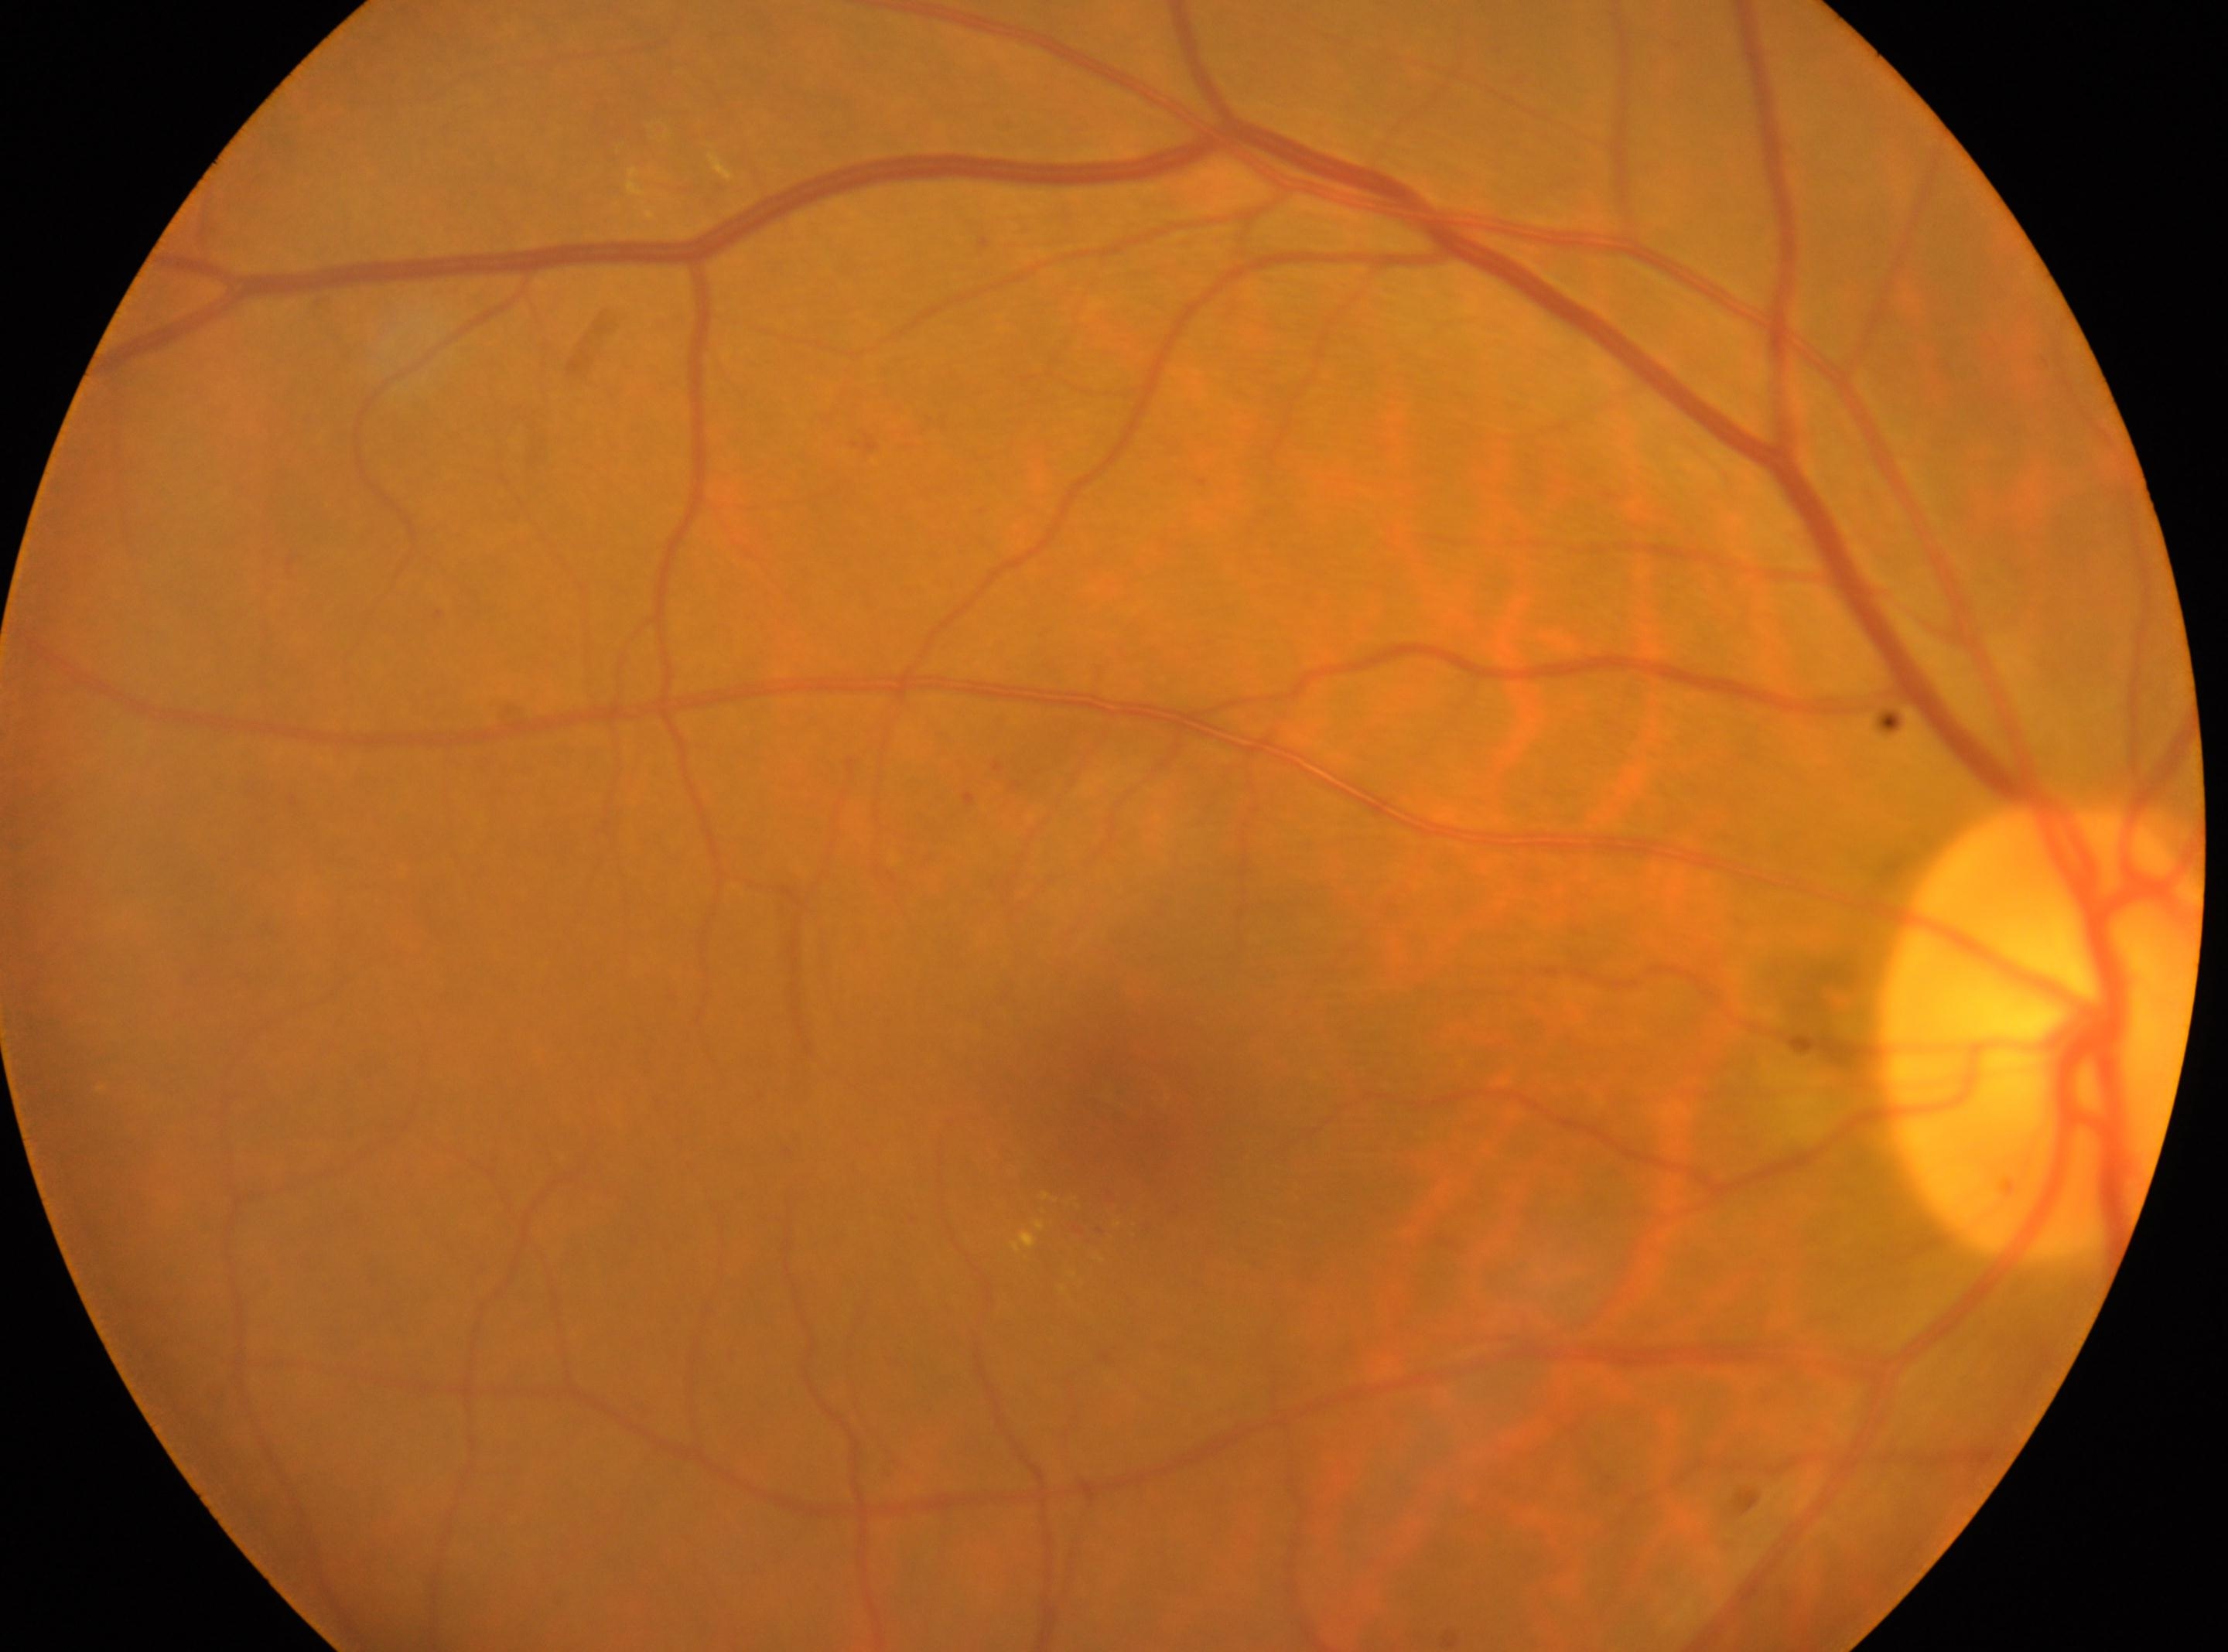 Eye: the right eye. Diabetic retinopathy severity is 2/4. Optic disk: (2039,1029). Macula center: (1111,1128).